Optic disc region crop; non-mydriatic fundus camera:
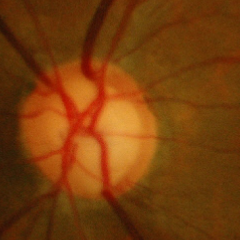 Glaucoma stage: early-stage glaucoma.